Tabletop color fundus camera image: 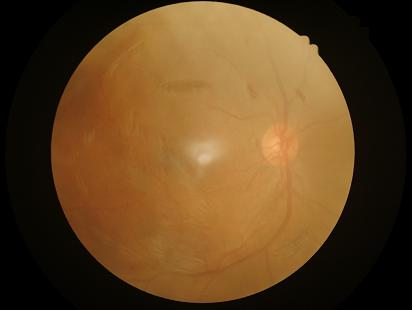
Image quality assessment:
- overall: inadequate for clinical interpretation
- illumination: inadequate, with uneven exposure or color distortion
- contrast: narrow intensity range, structures hard to distinguish
- focus: noticeable blur in the optic disc, vessels, or background